Tabletop color fundus camera image — 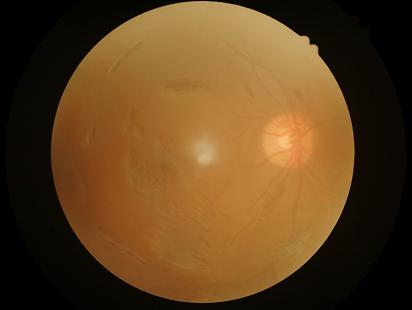
Image quality: contrast: reduced | sharpness: poor | illumination: suboptimal | overall: inadequate.